NIDEK AFC-230, 848x848px, 45° field of view.
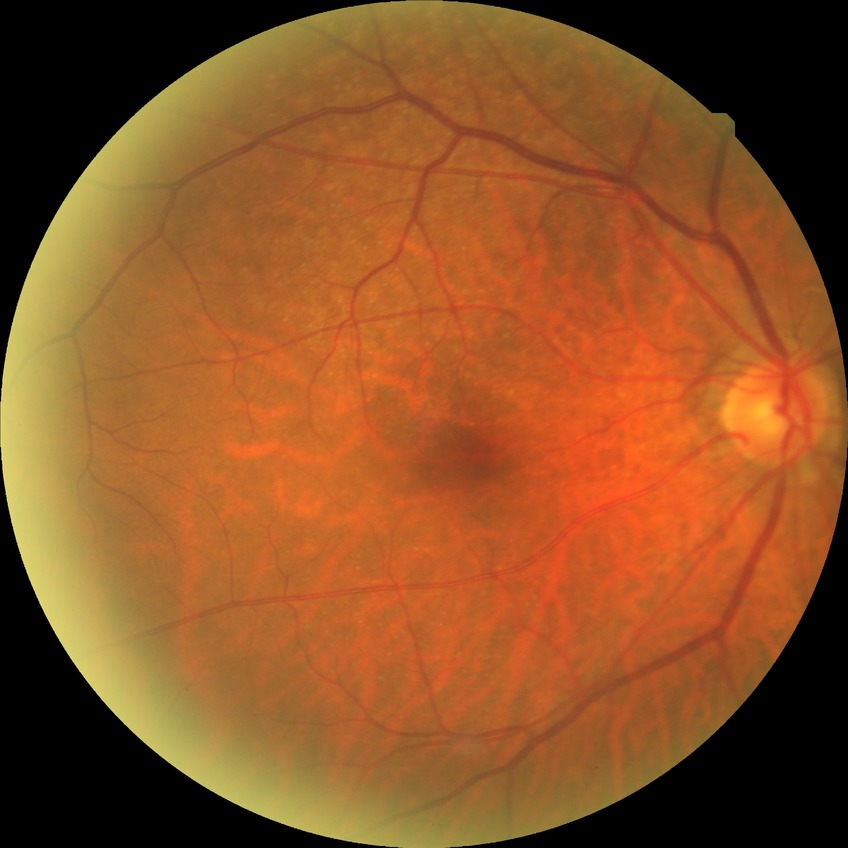

No apparent diabetic retinopathy.
Davis DR grade is NDR.